Wide-field retinal mosaic image: 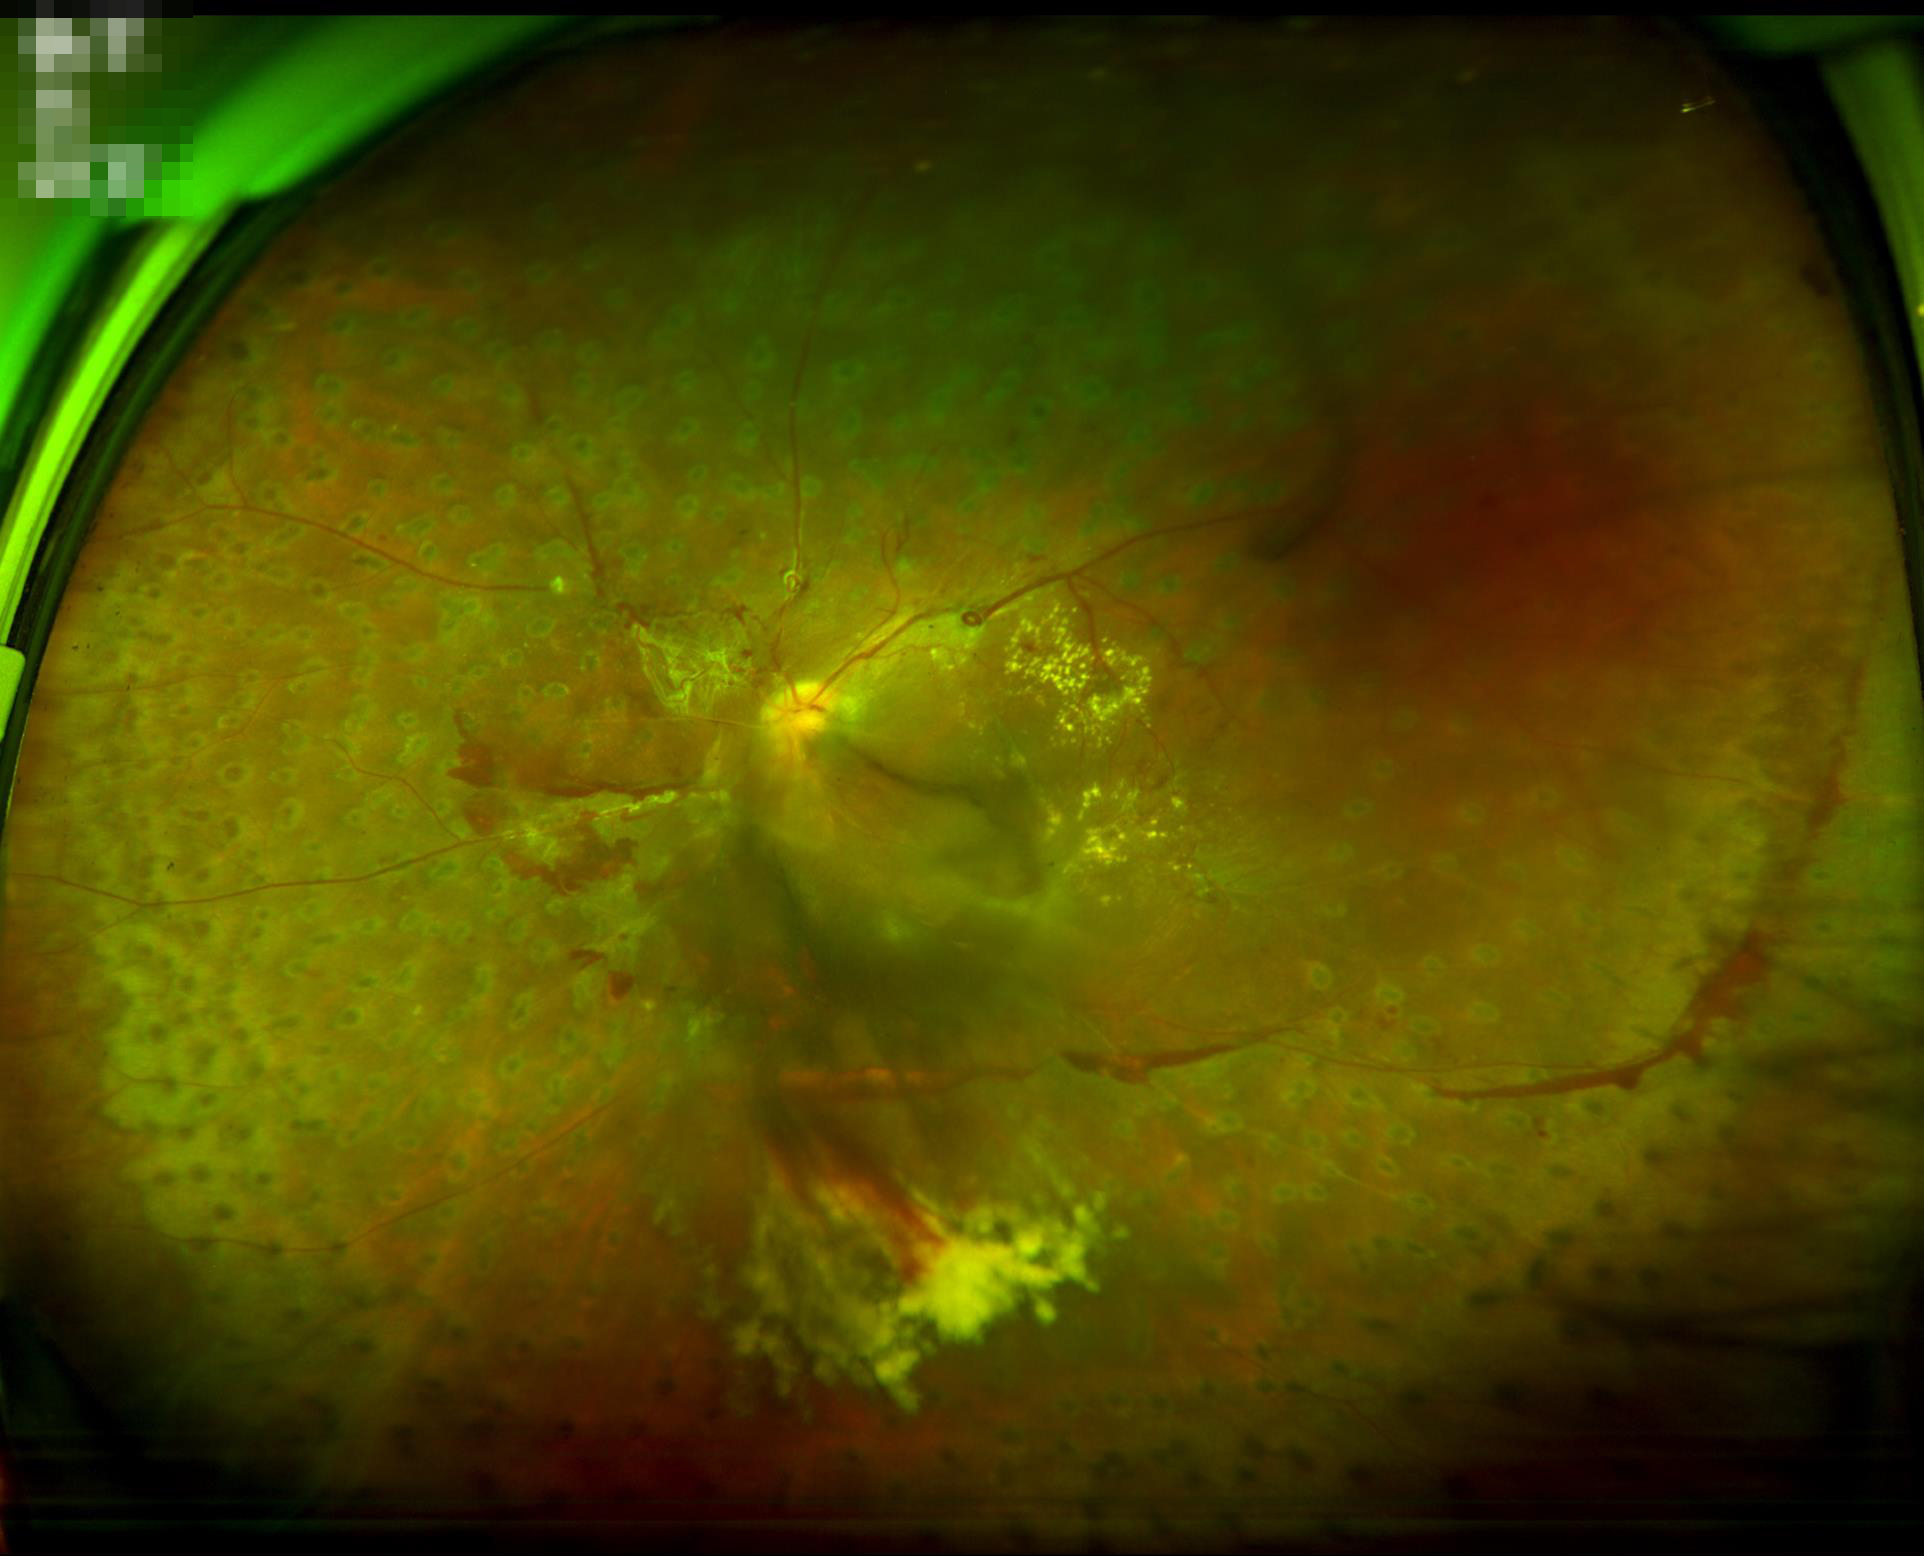

Illumination/color = good; Clarity = out of focus; Overall = inadequate.